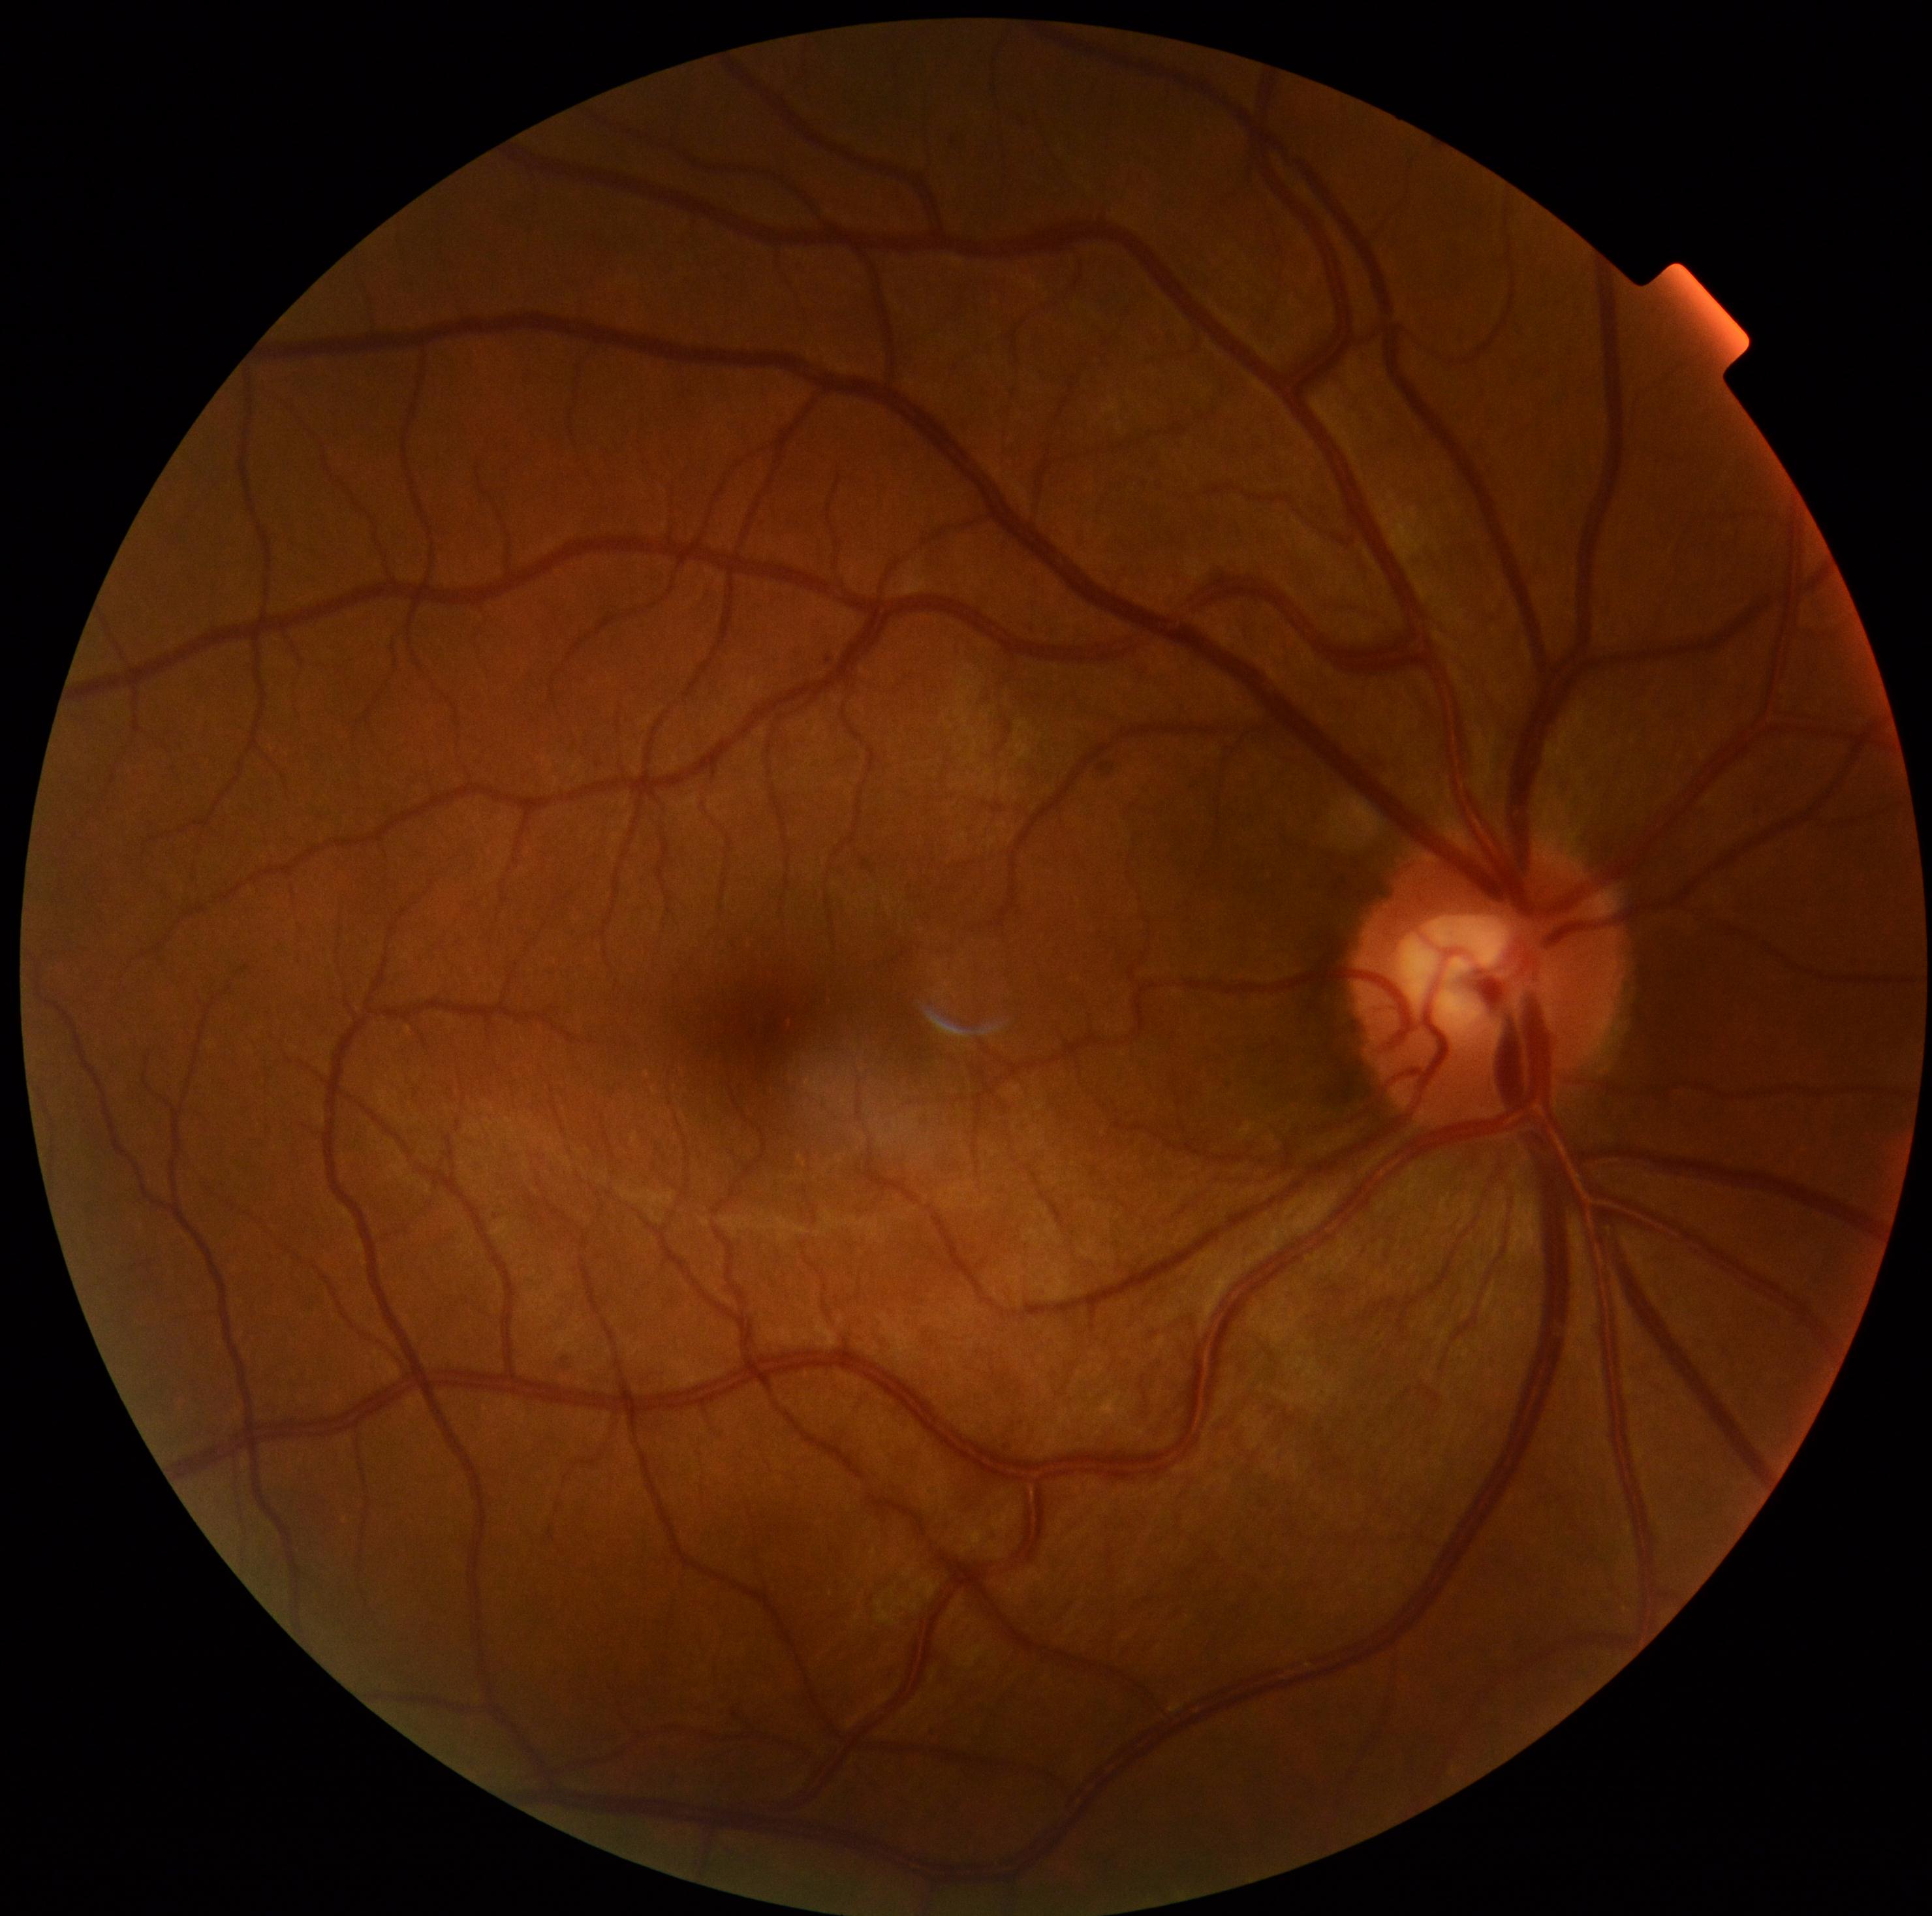
  dr_grade: 0 — no visible signs of diabetic retinopathy
  dr_impression: negative for DR